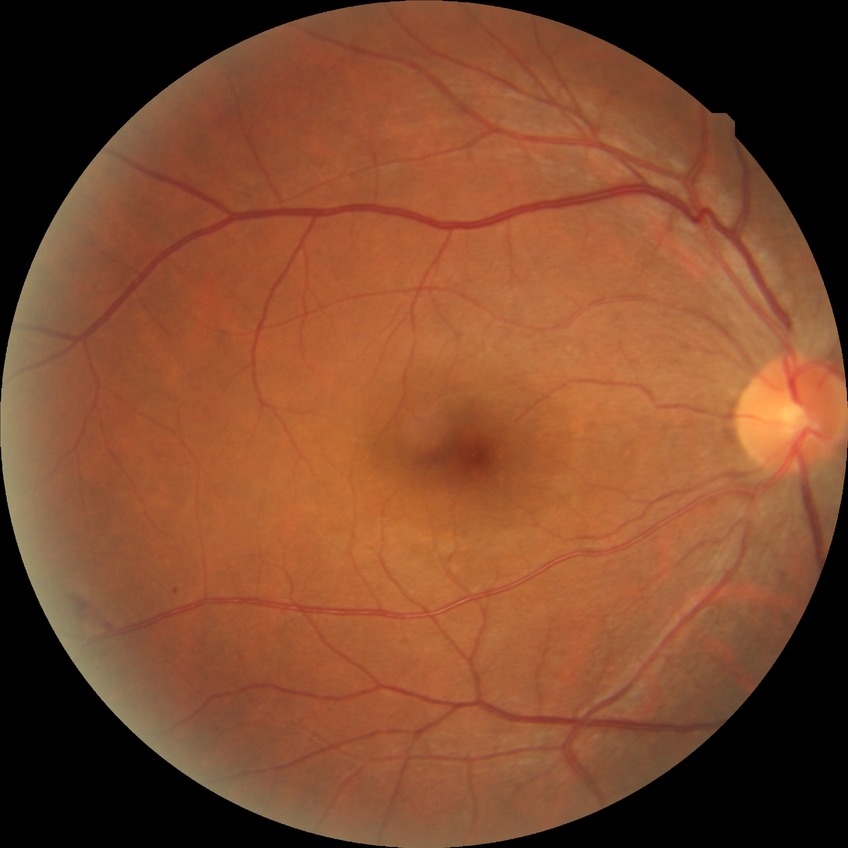 diabetic retinopathy (DR)@SDR (simple diabetic retinopathy), DR class@non-proliferative diabetic retinopathy.